Posterior pole view · fundus photo — 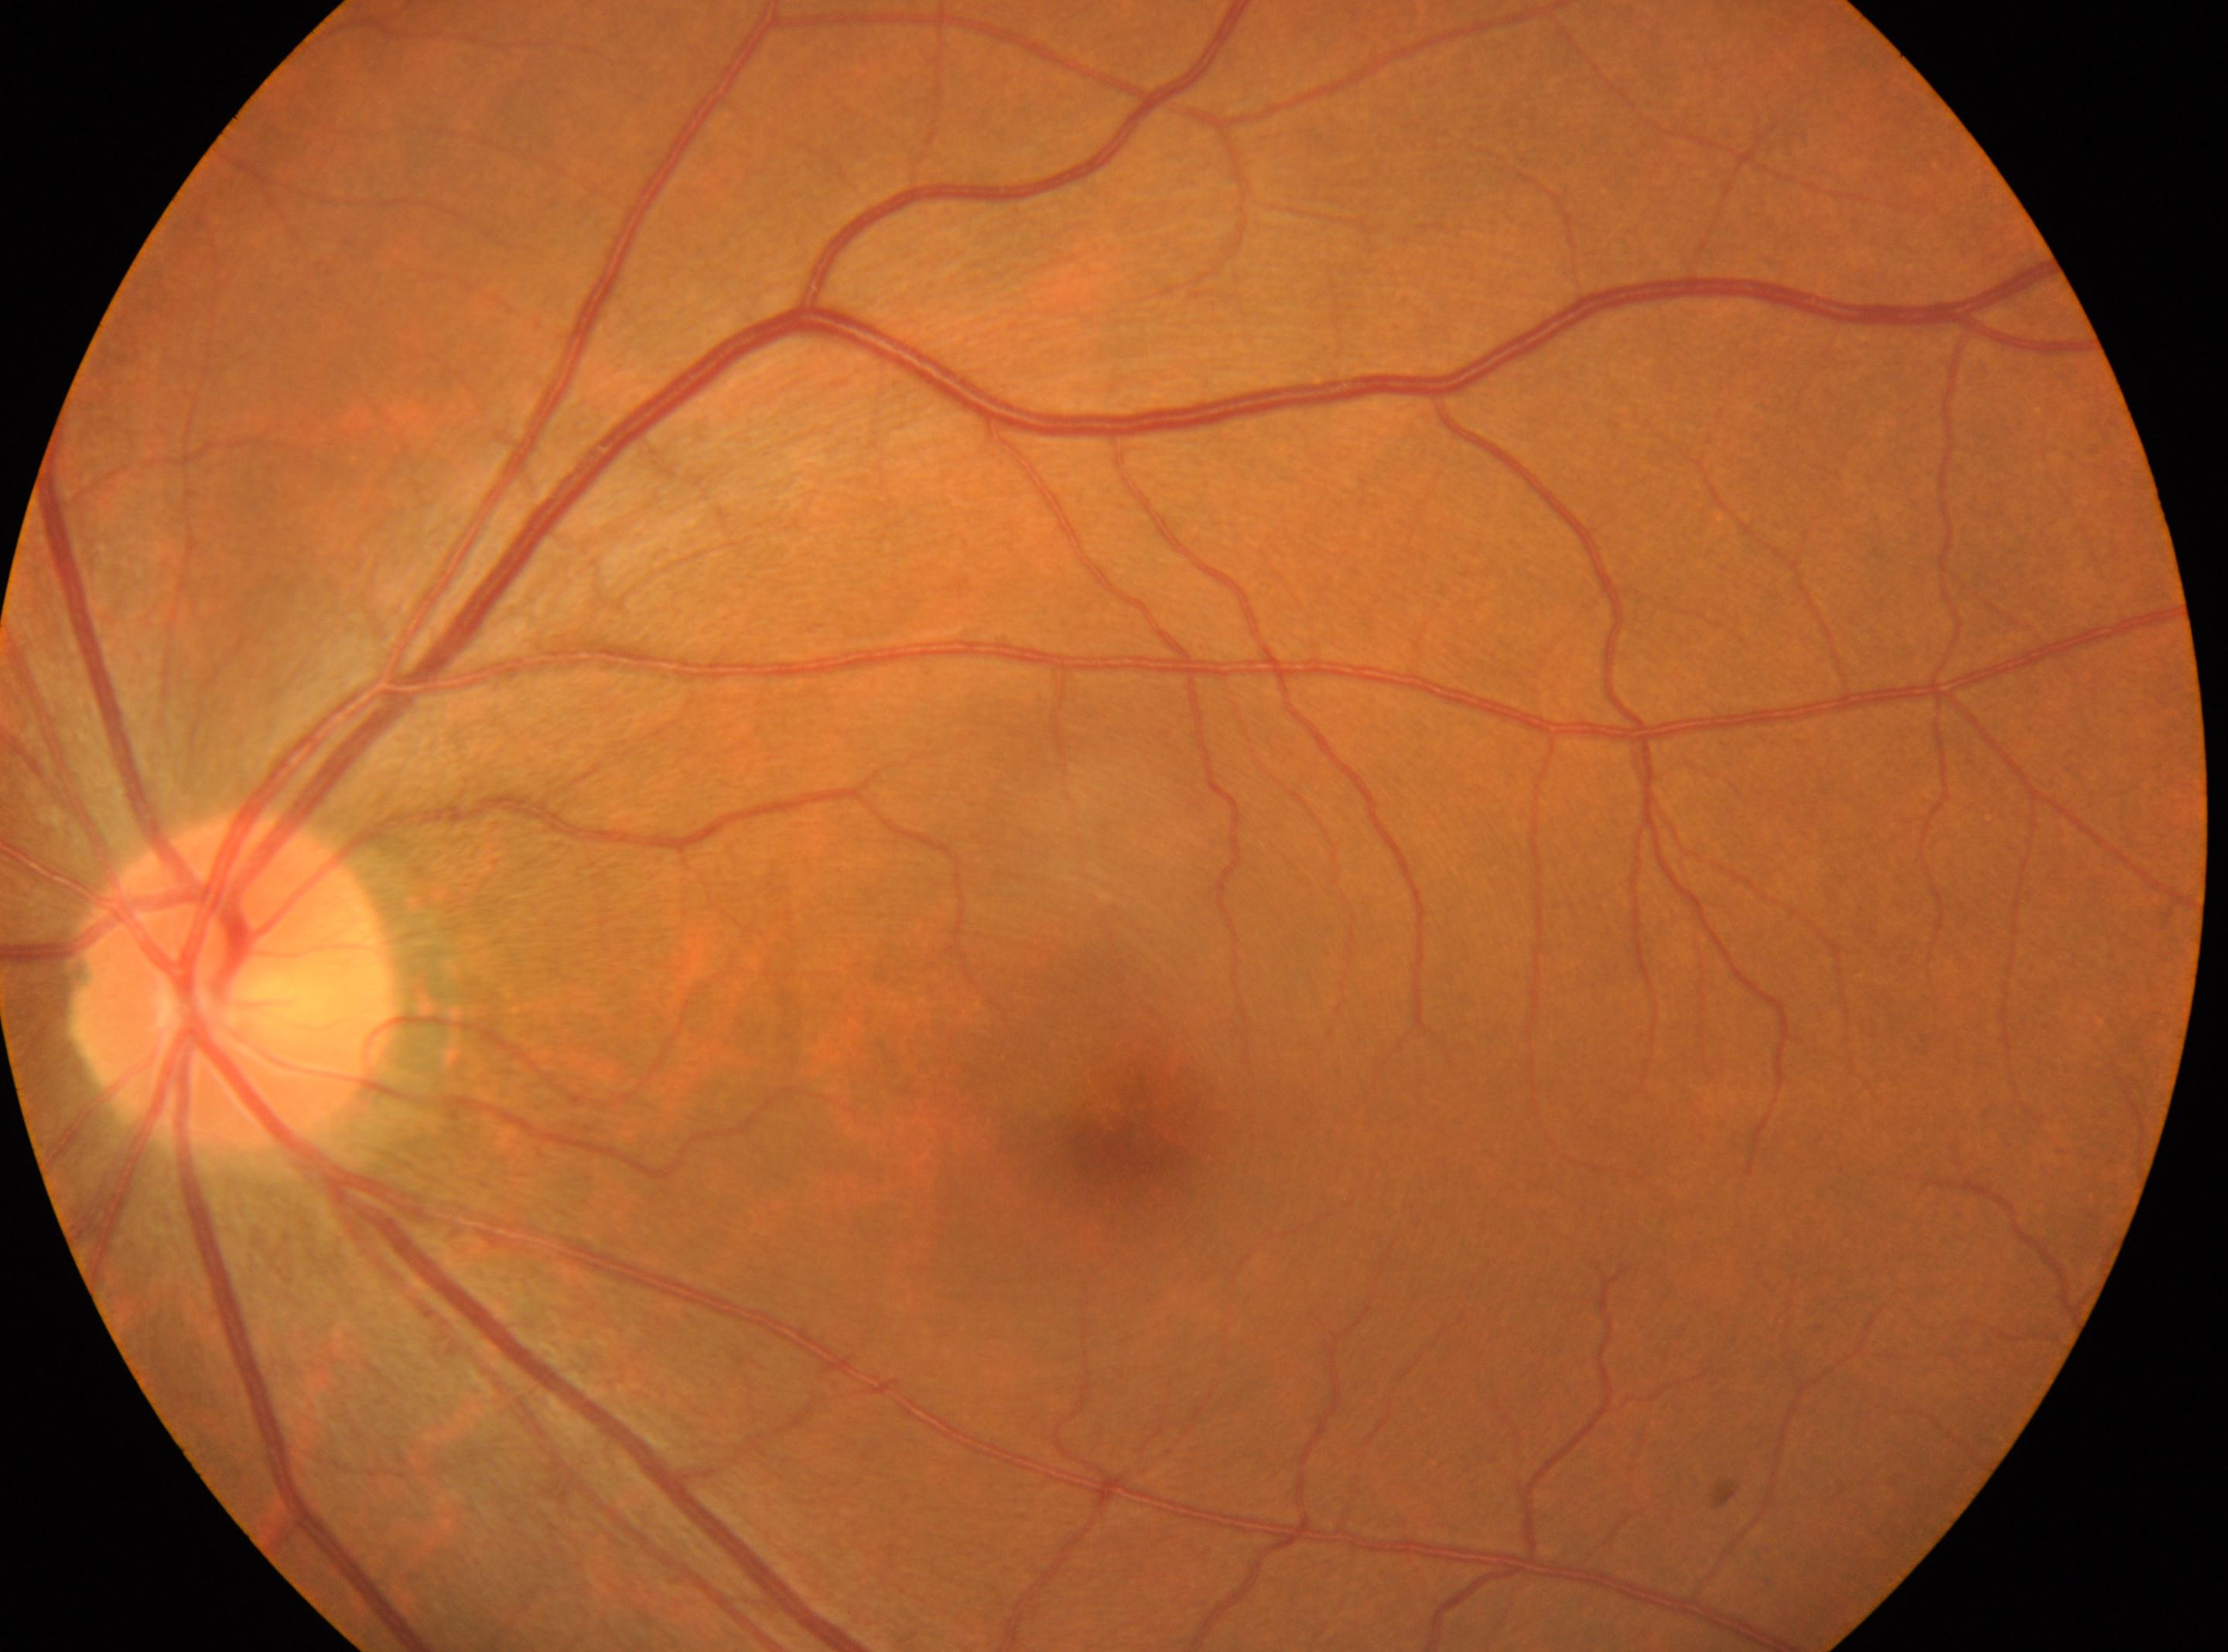 Findings:
– diabetic retinopathy (DR) · grade 0 — no visible signs of diabetic retinopathy
– laterality · left eye
– fovea · 1134, 1128
– ONH · 231, 982